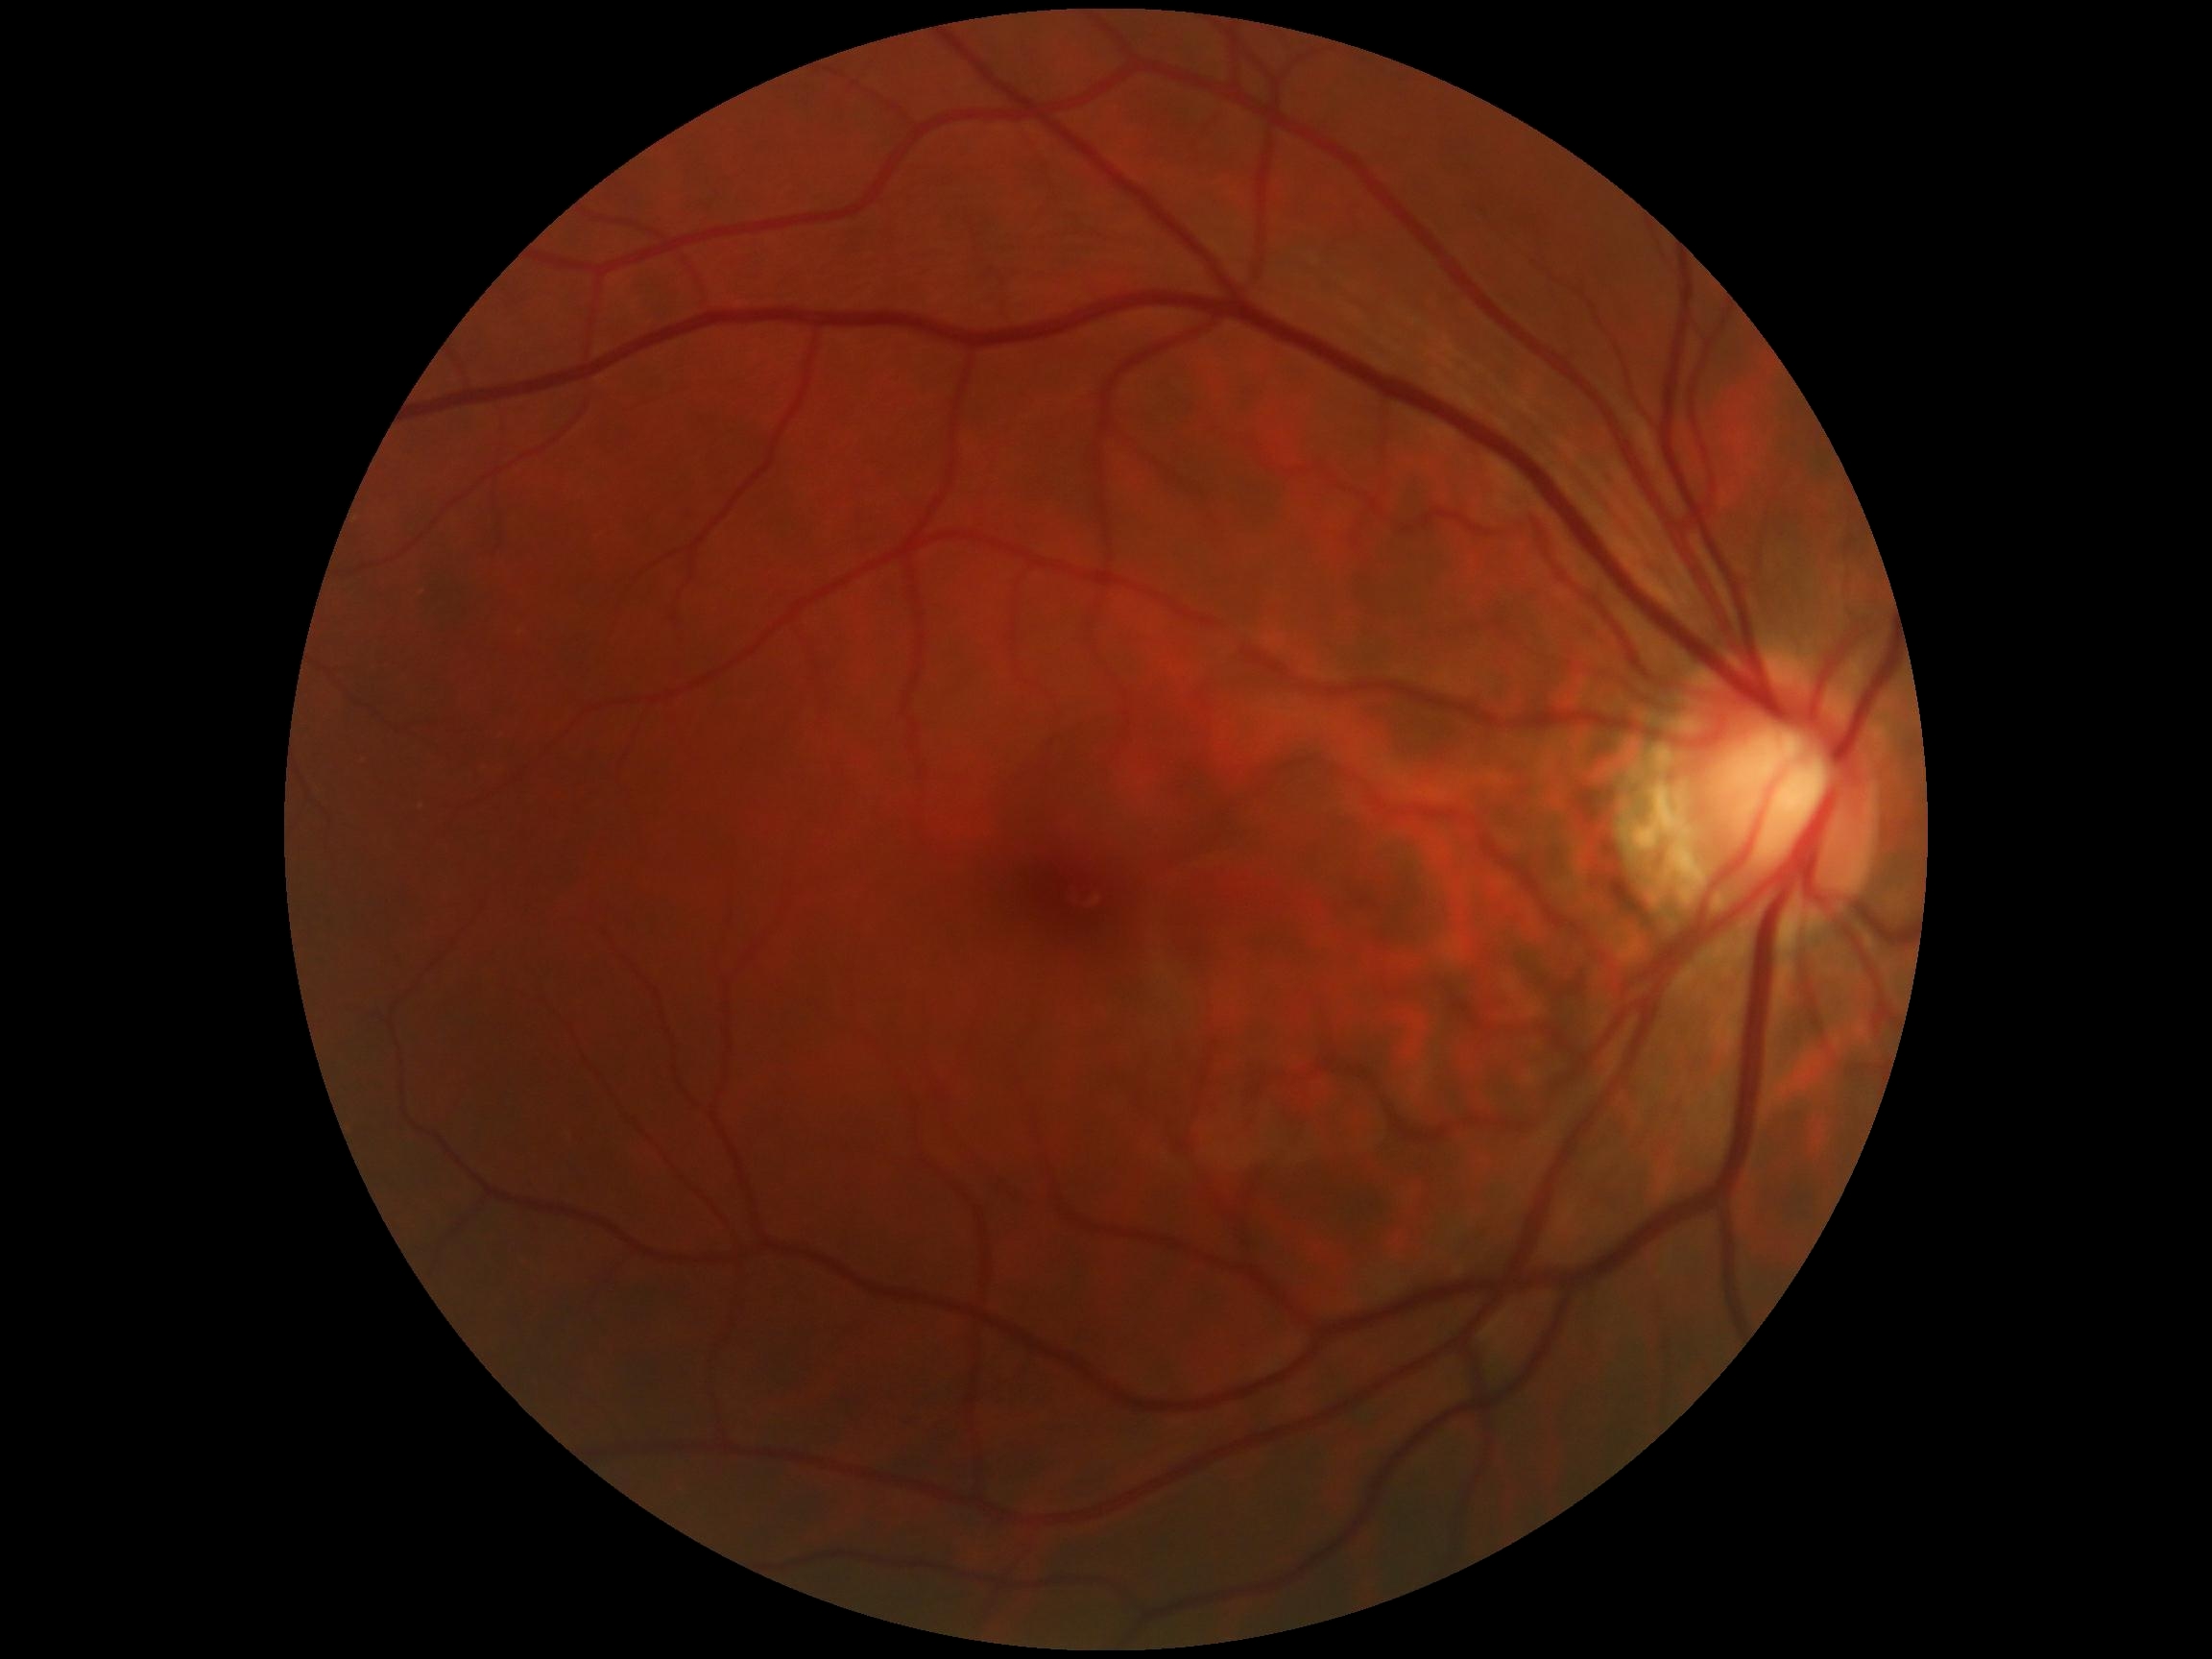
No DR findings.
DR grade: 0.